Camera: NIDEK AFC-230 · 848x848px · no pharmacologic dilation
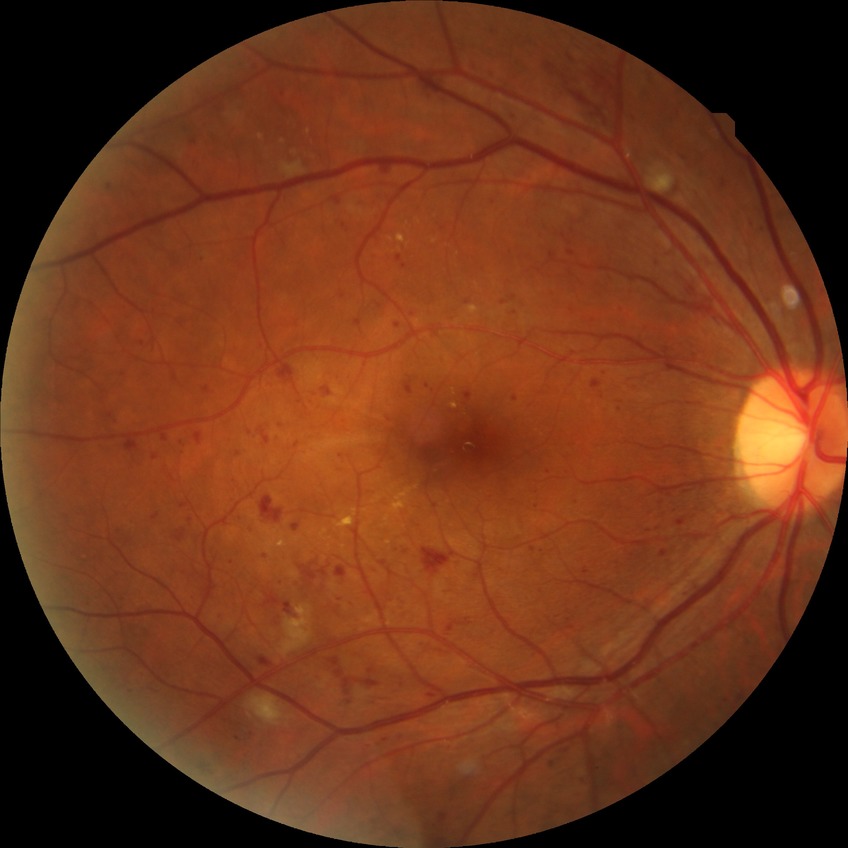 Diabetic retinopathy grade is pre-proliferative diabetic retinopathy.